Pediatric retinal photograph (wide-field). 640x480
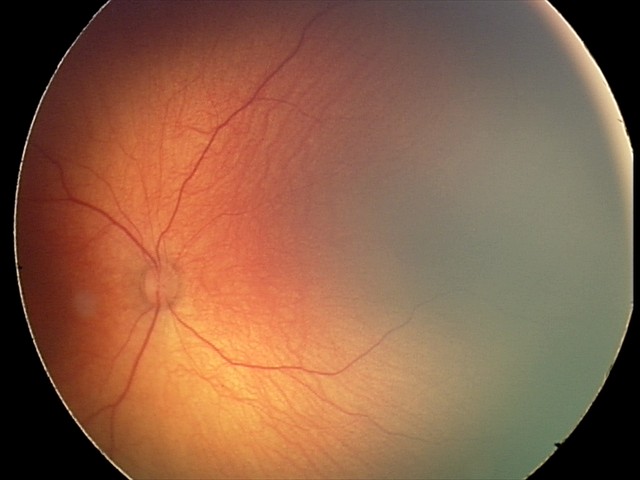 Physiological retinal appearance for postconceptual age.